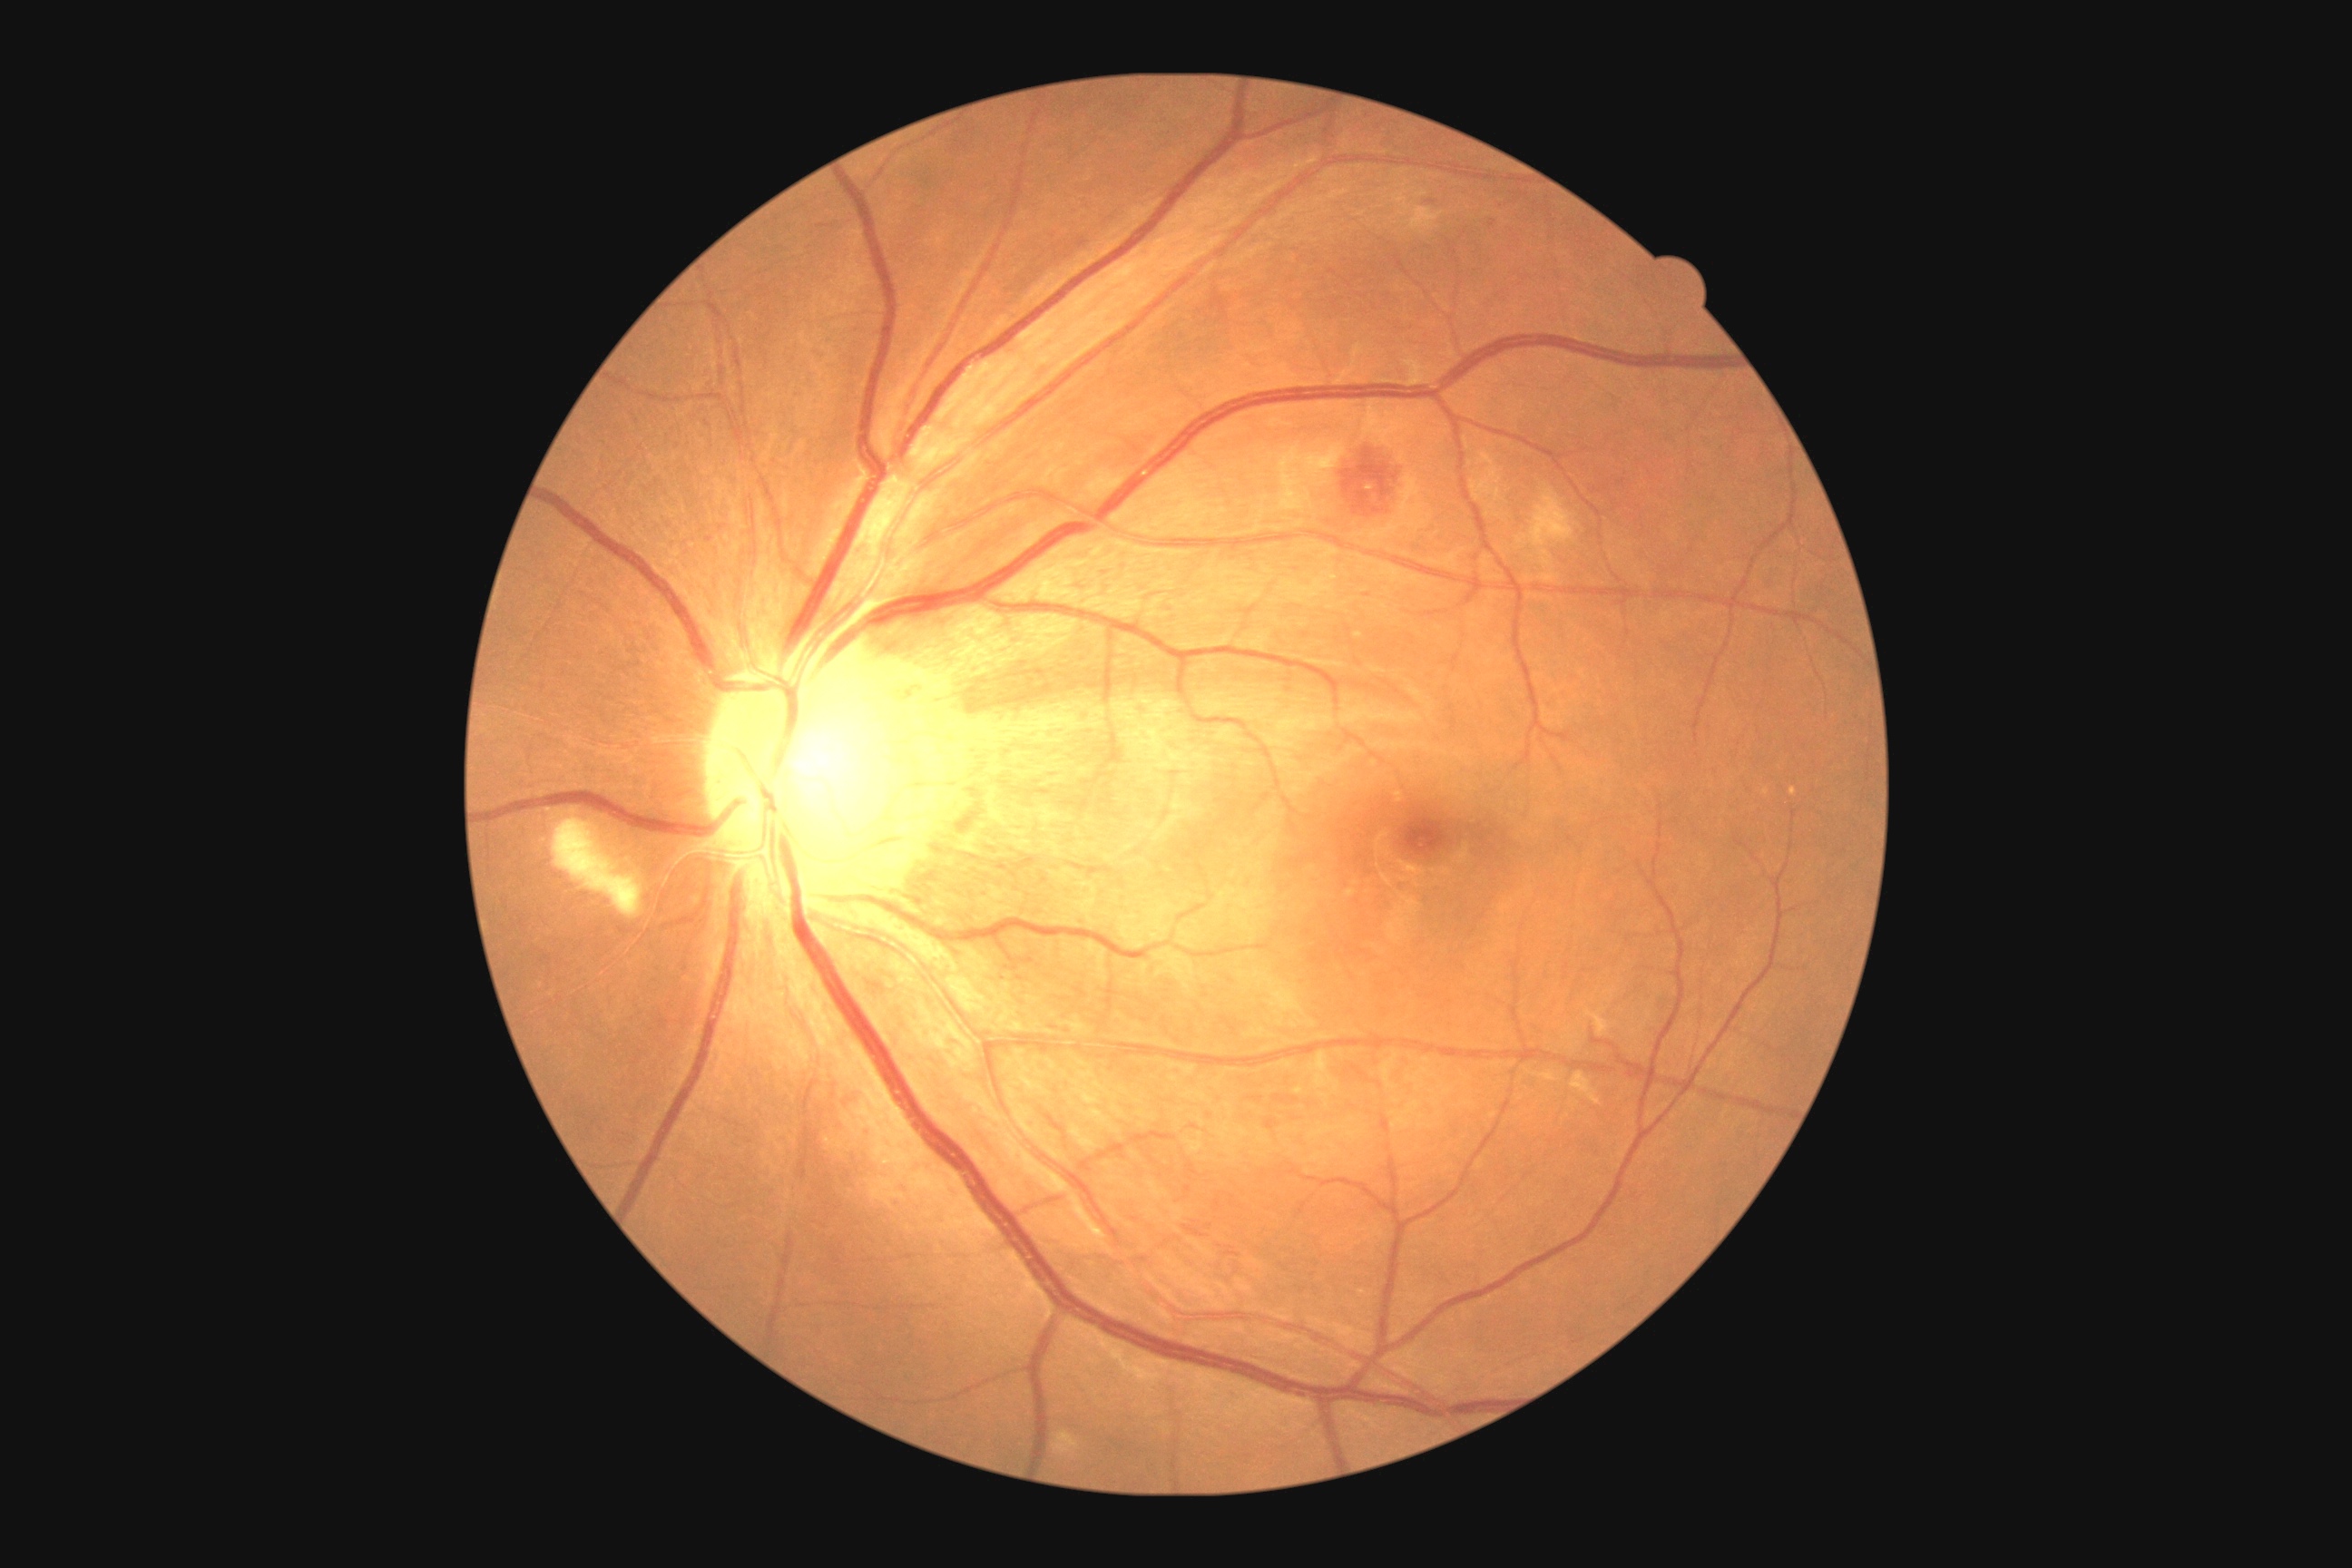
diabetic retinopathy (DR): moderate non-proliferative diabetic retinopathy (grade 2).